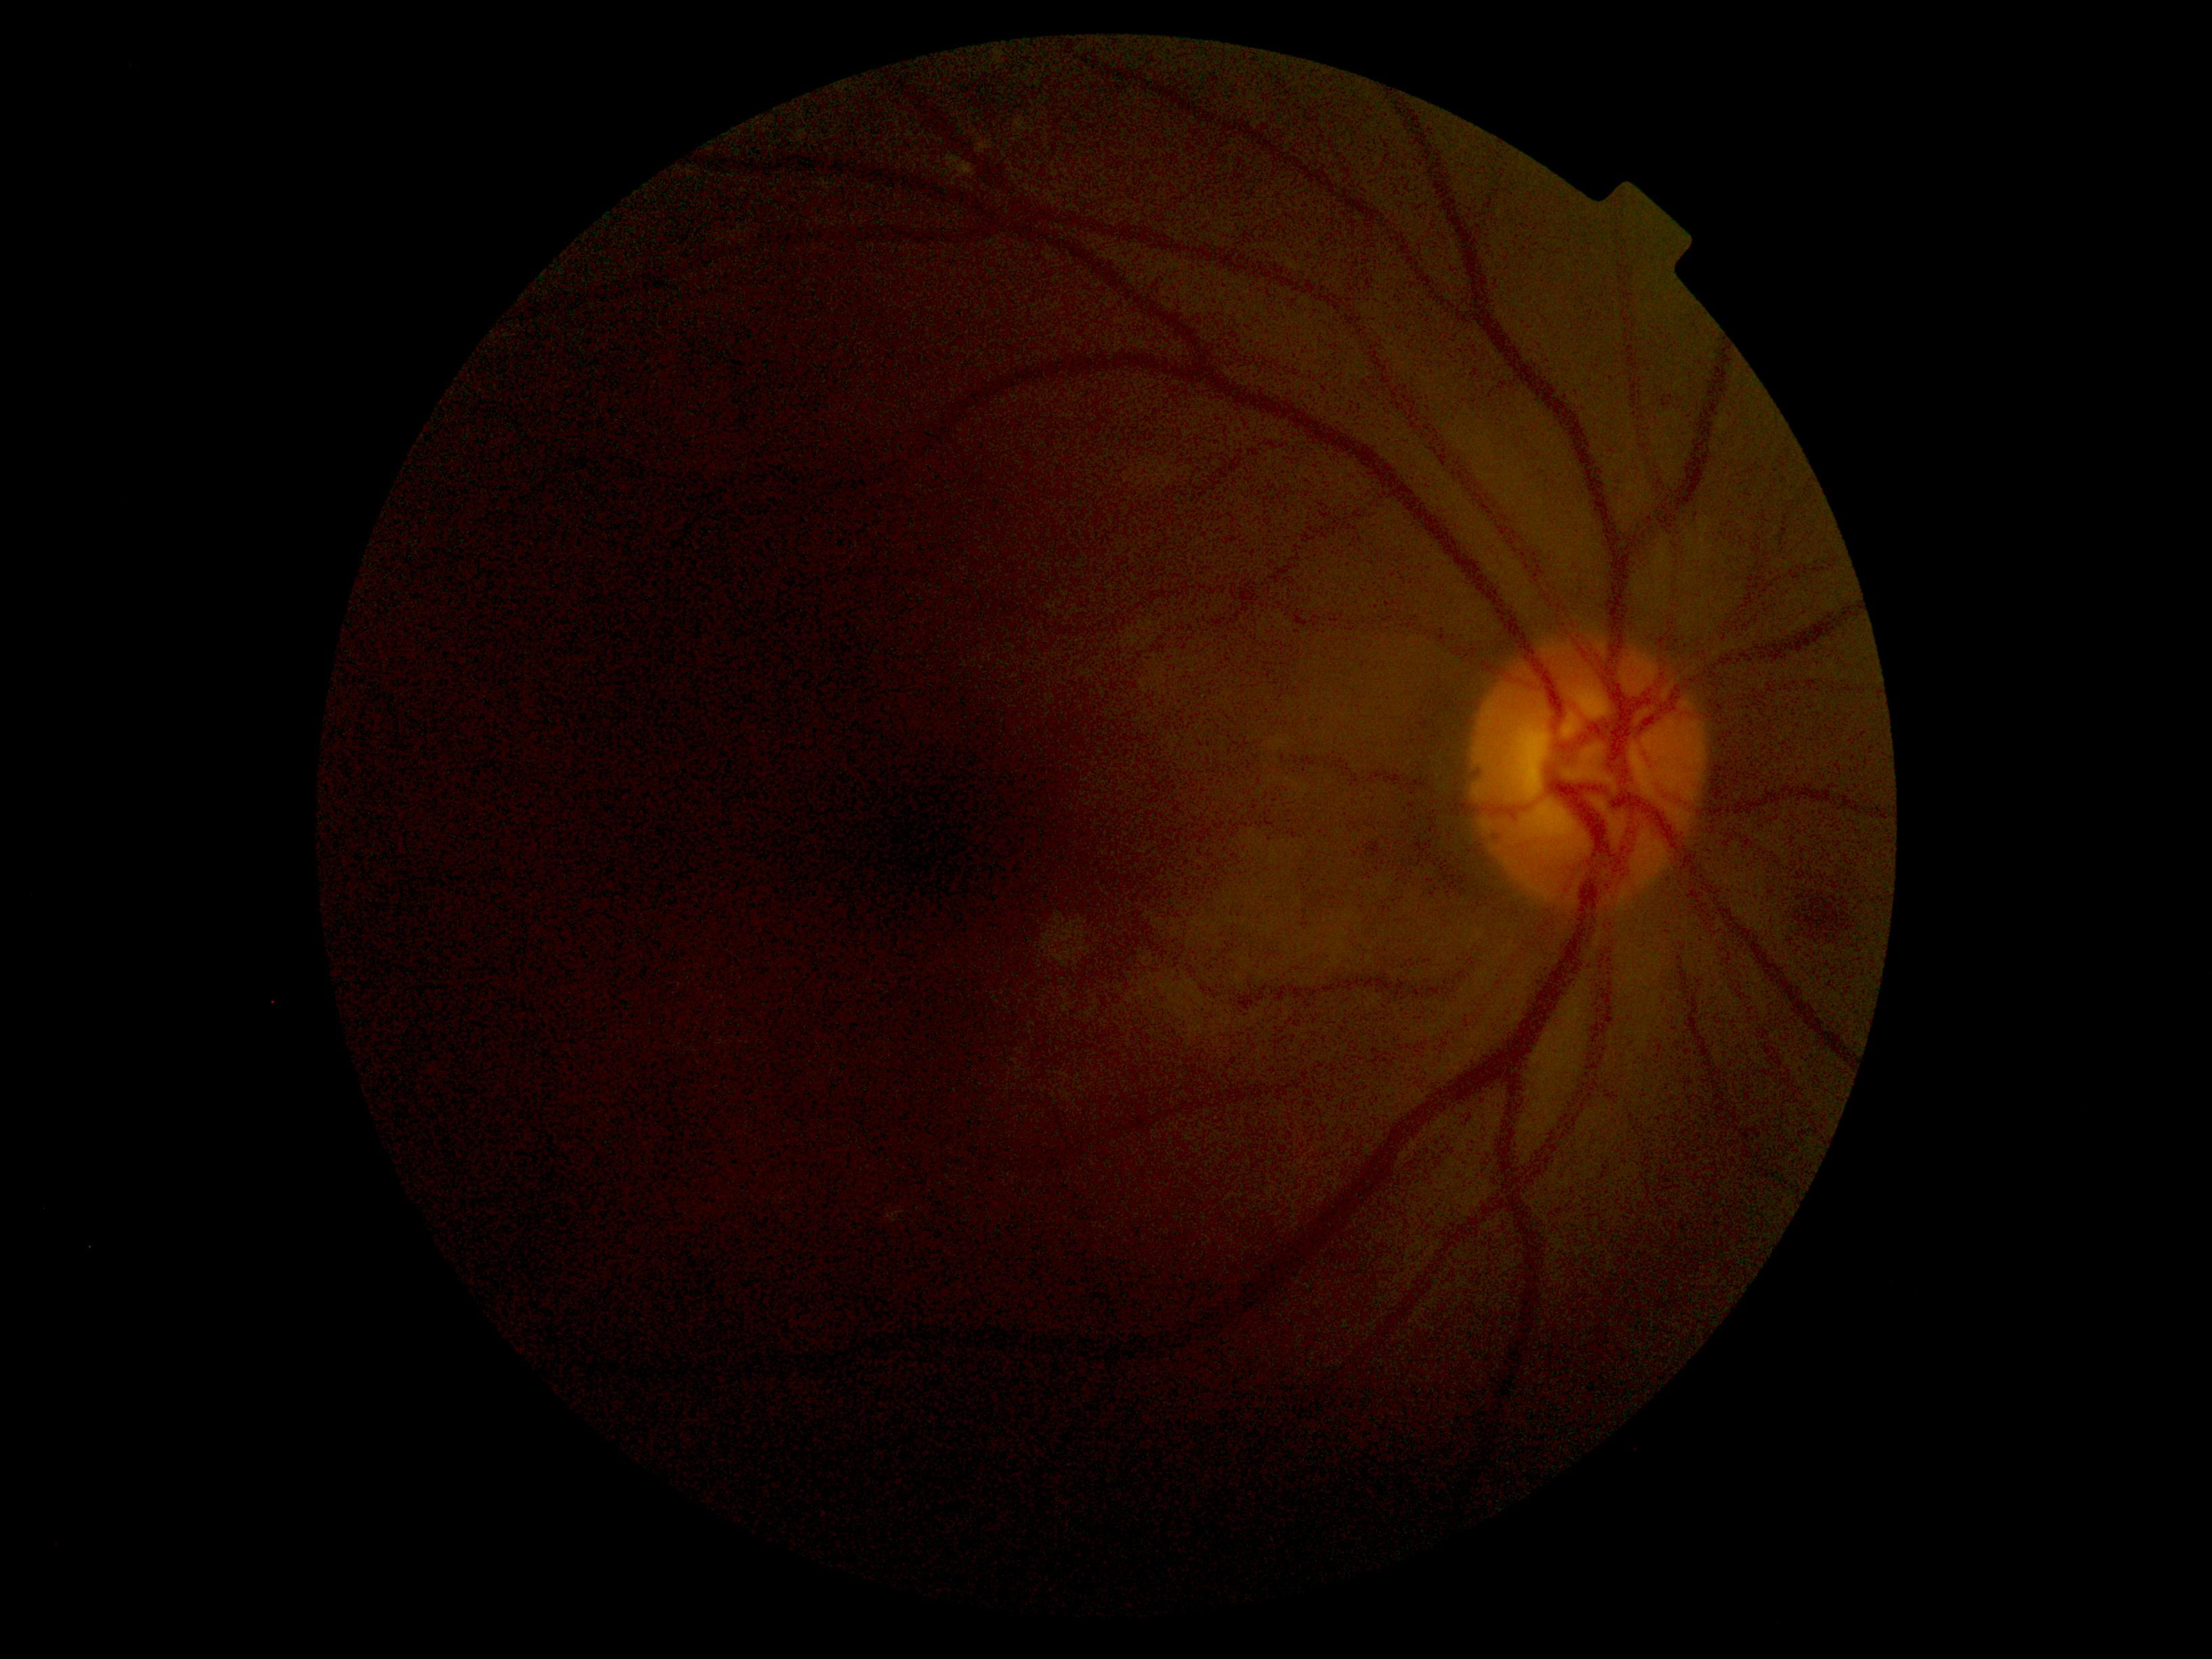
DR stage is 2/4.